FOV: 45 degrees
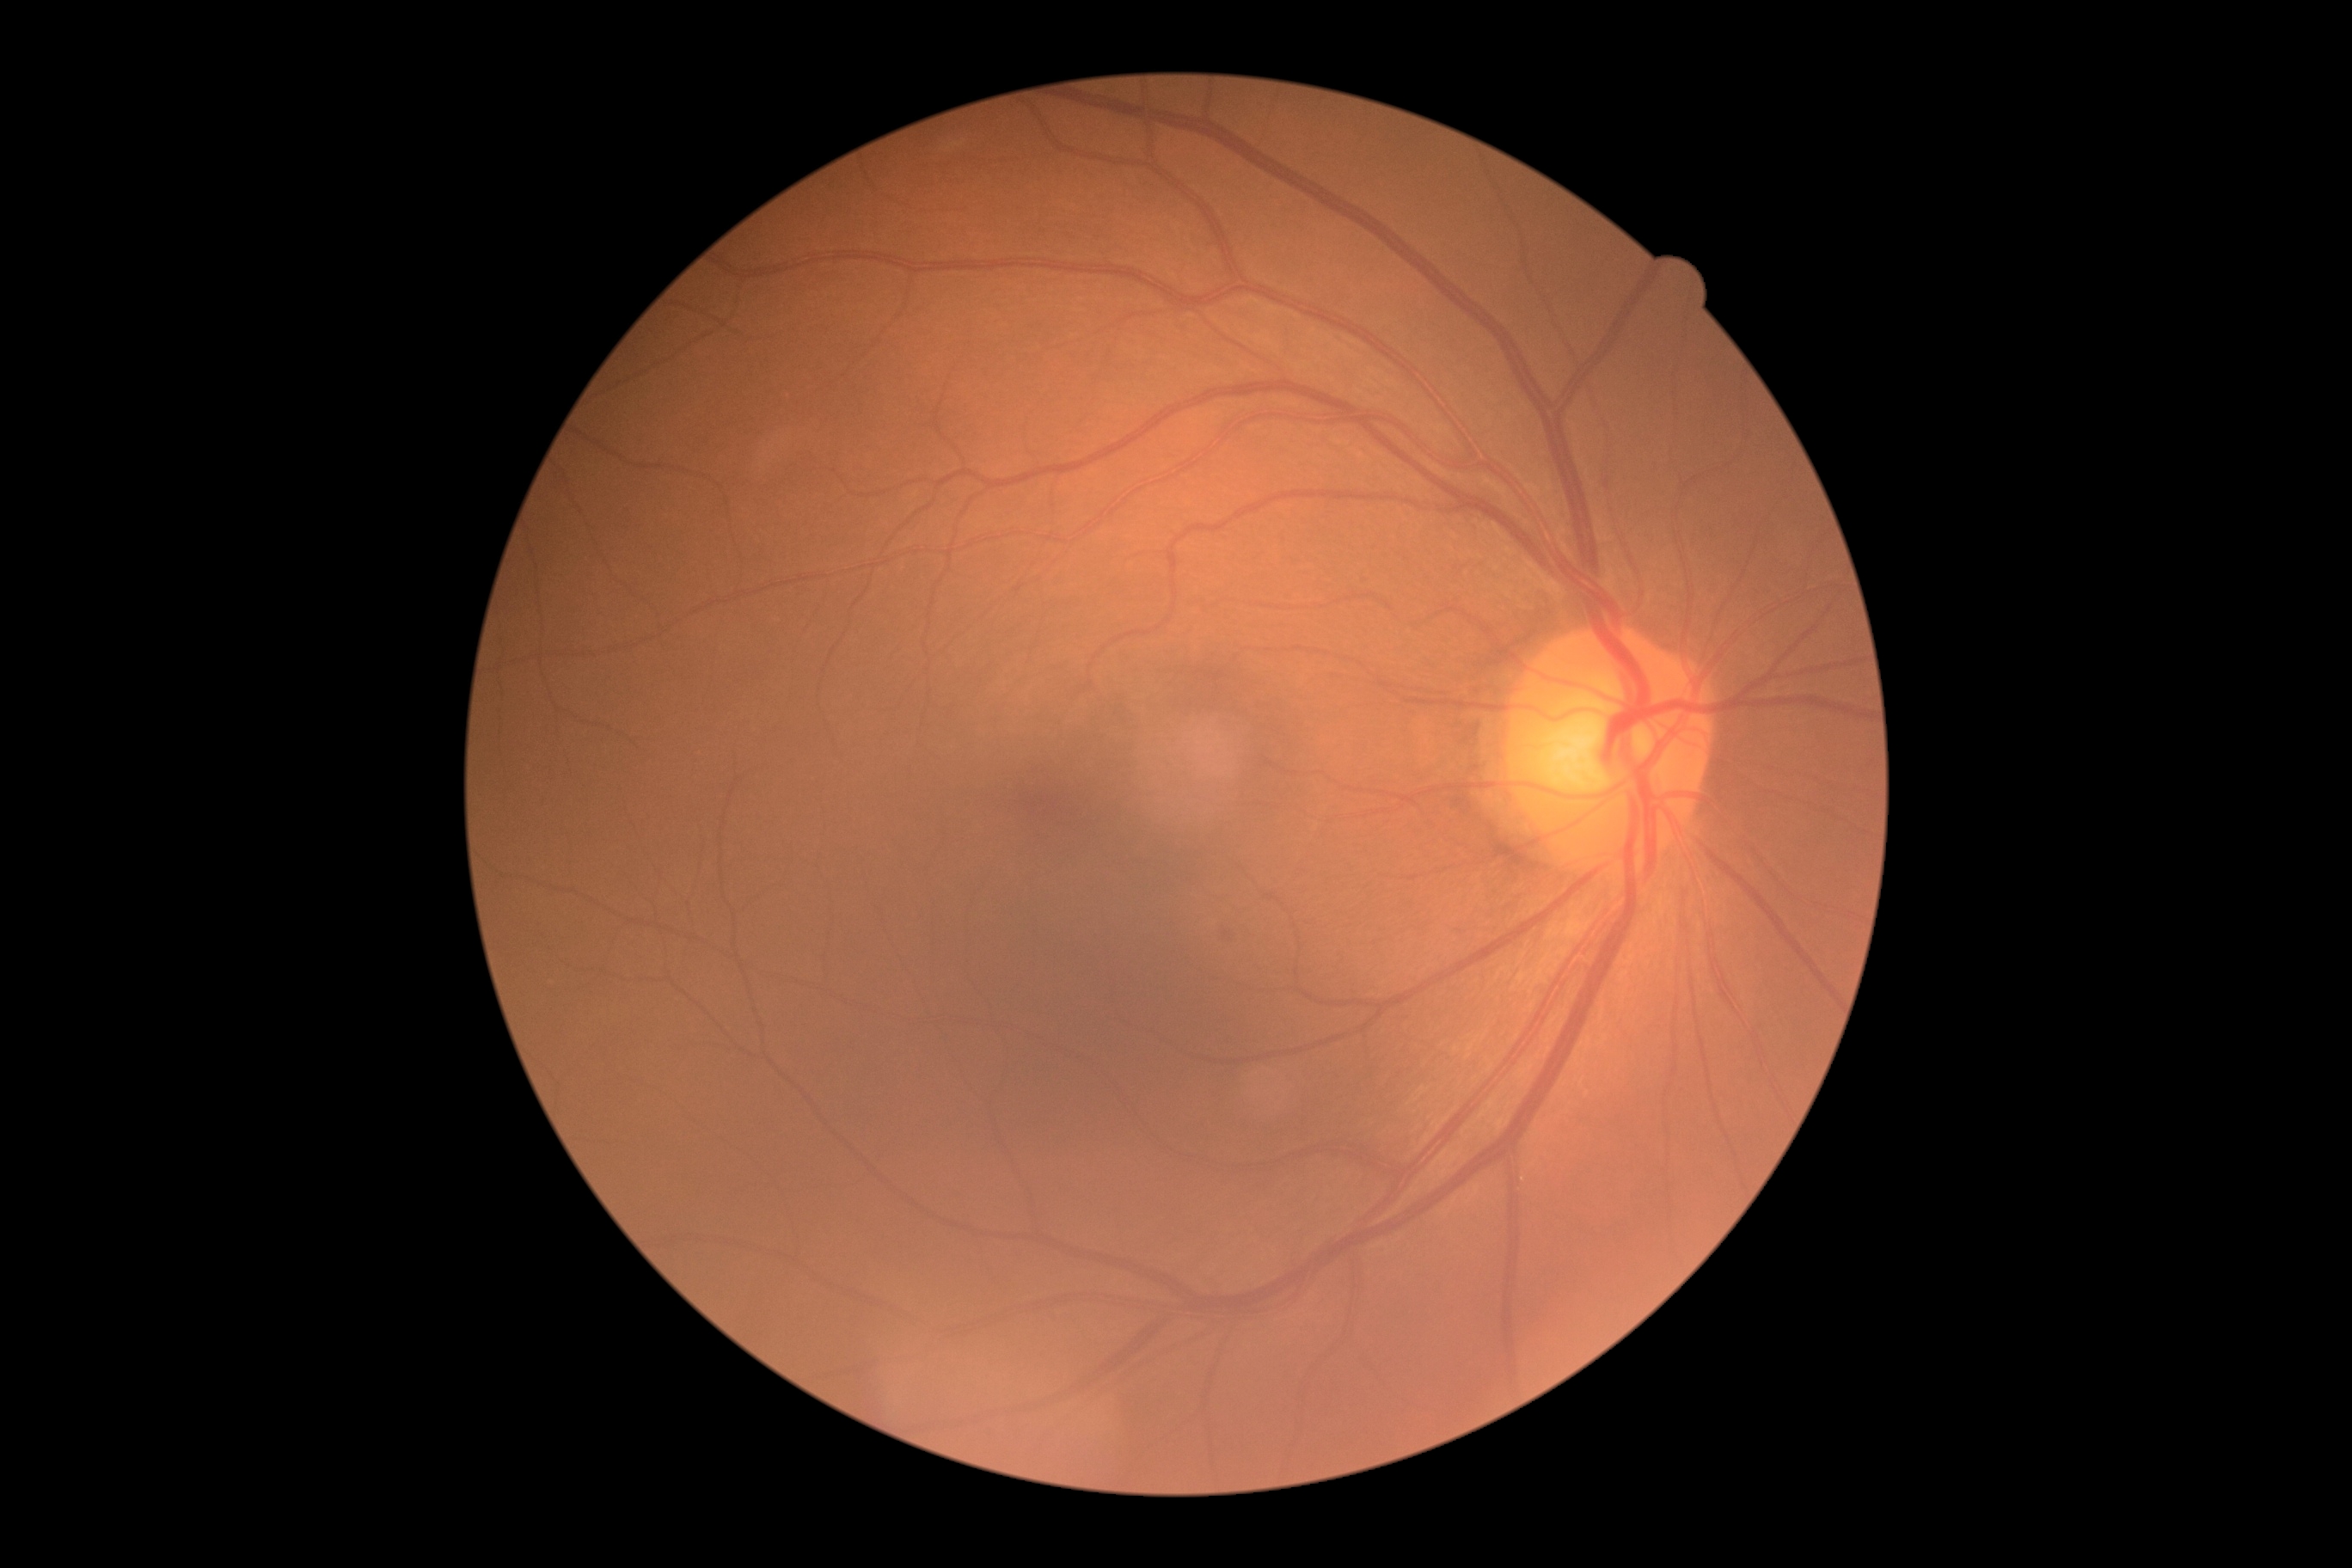
diabetic retinopathy grade: 1 (mild NPDR).